45° field of view; 2352 x 1568 pixels; fundus photo: 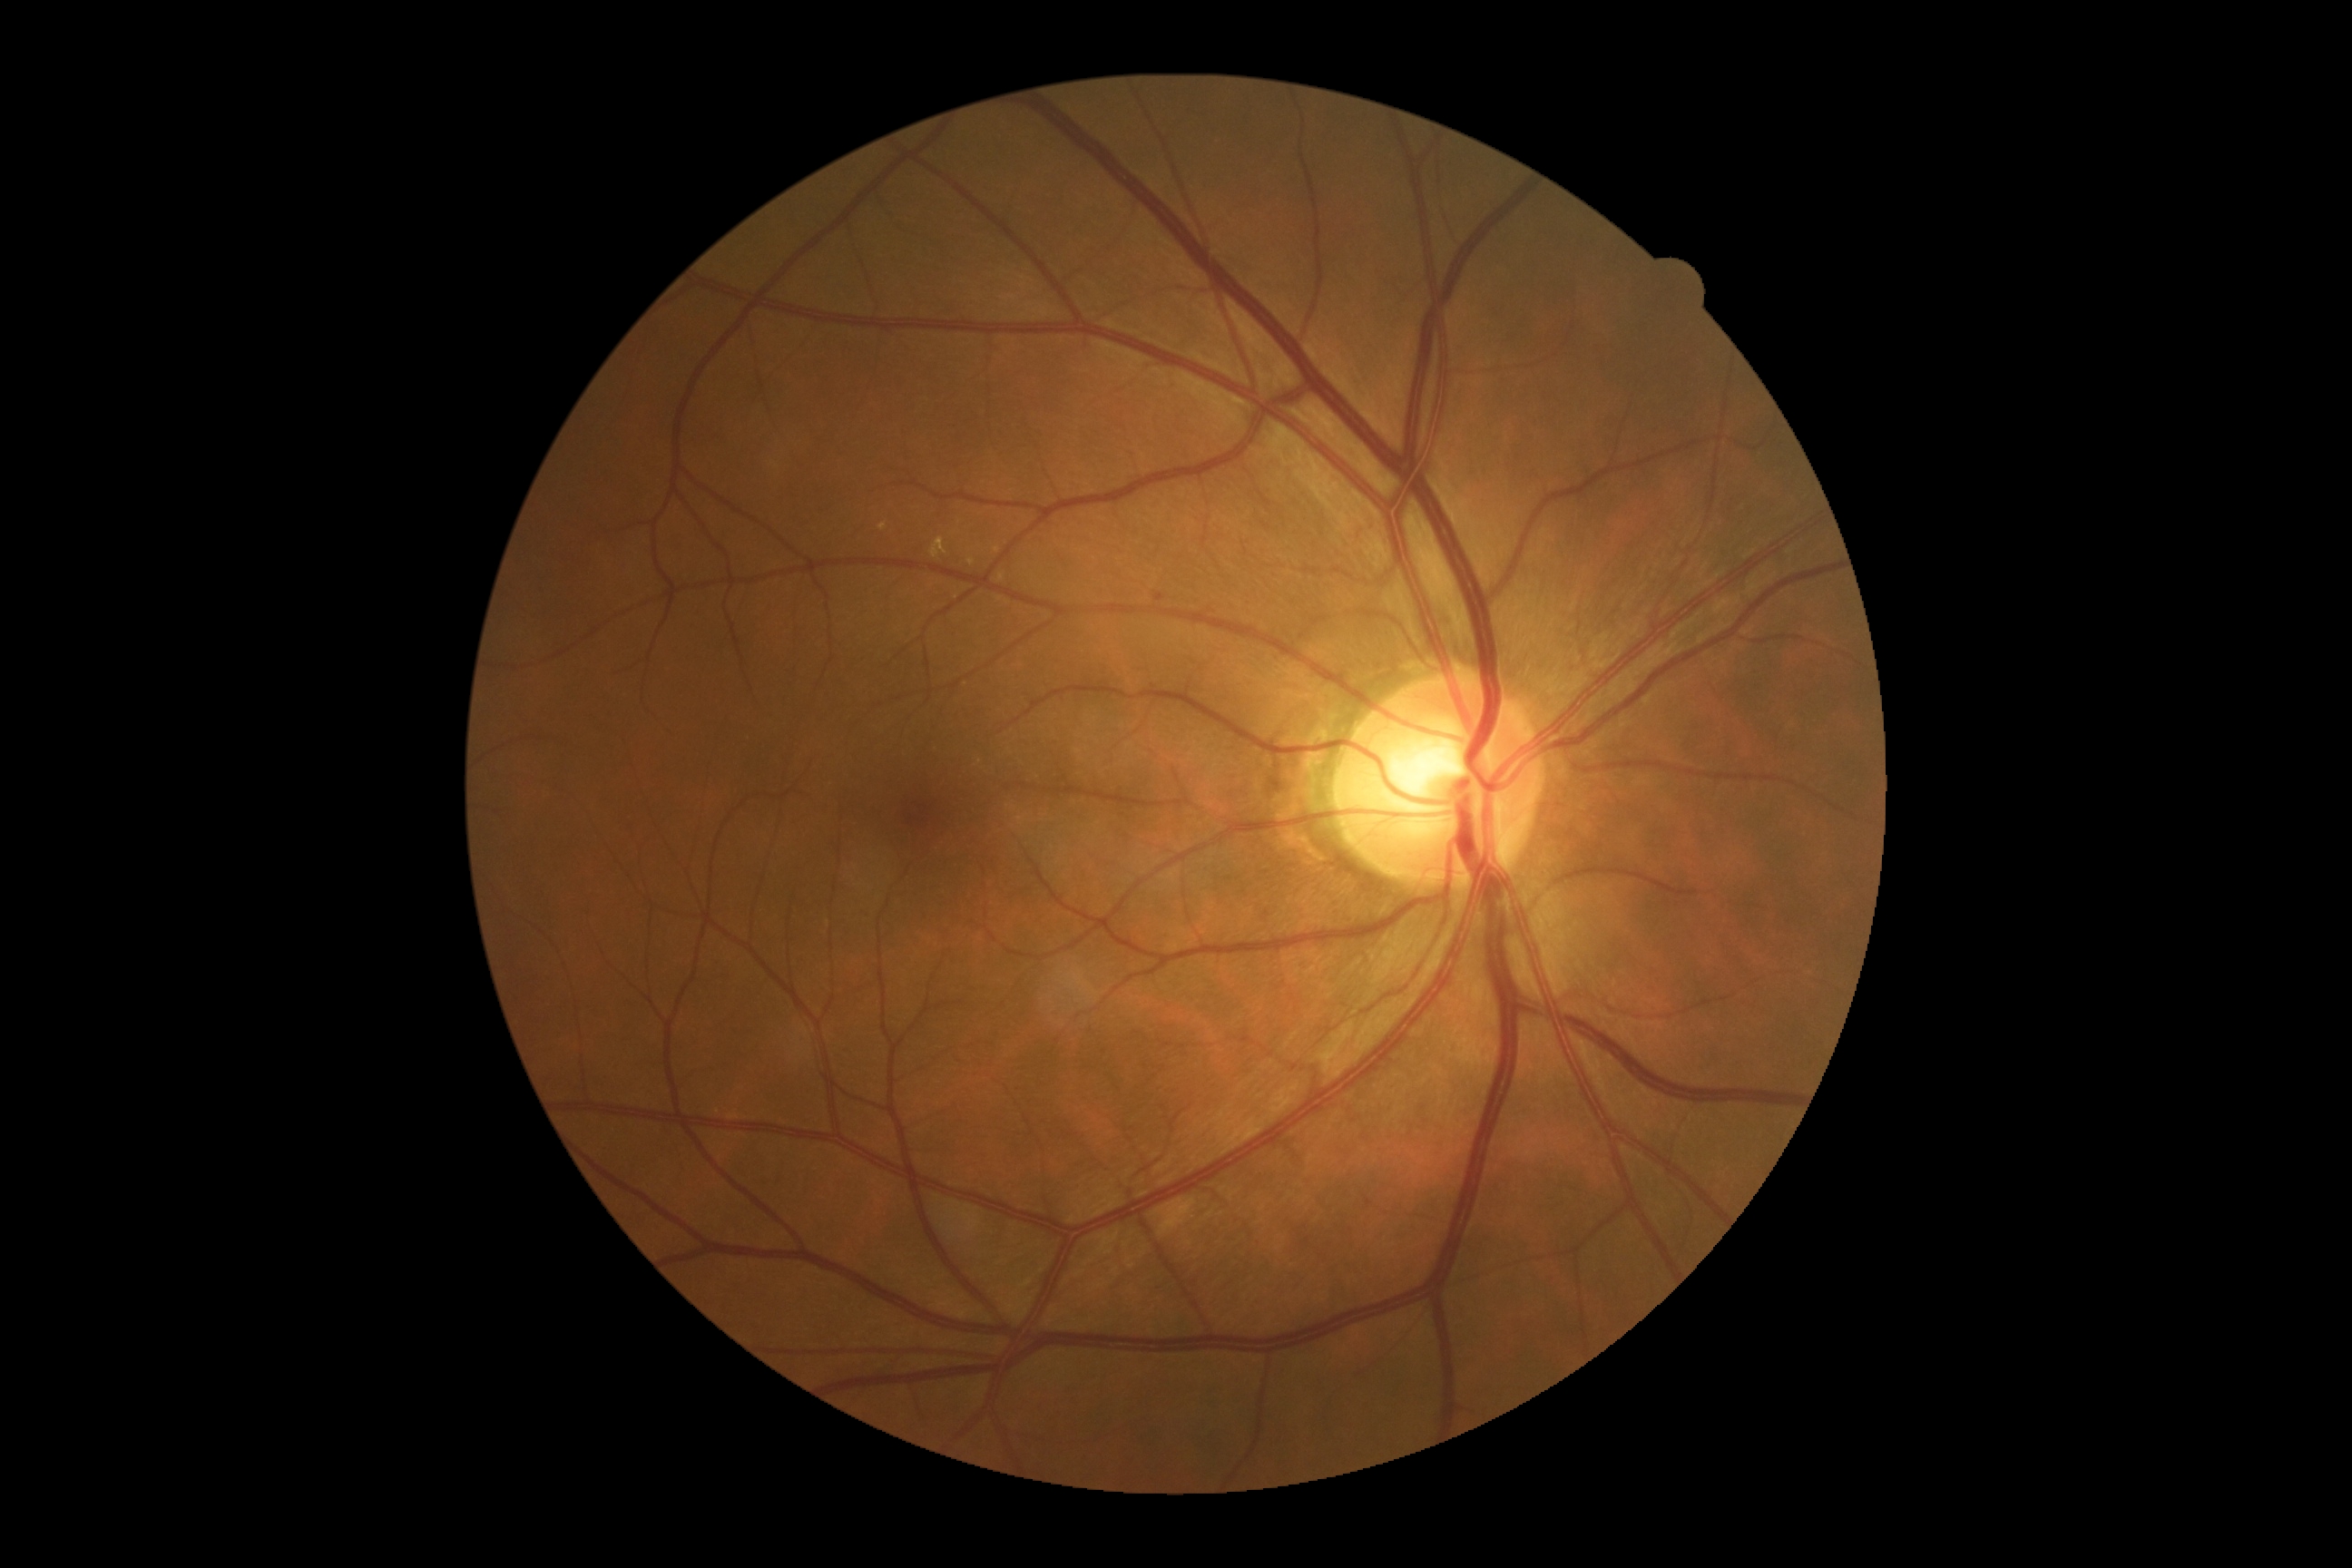

Diabetic retinopathy (DR): grade 2.
Disease class: non-proliferative diabetic retinopathy.